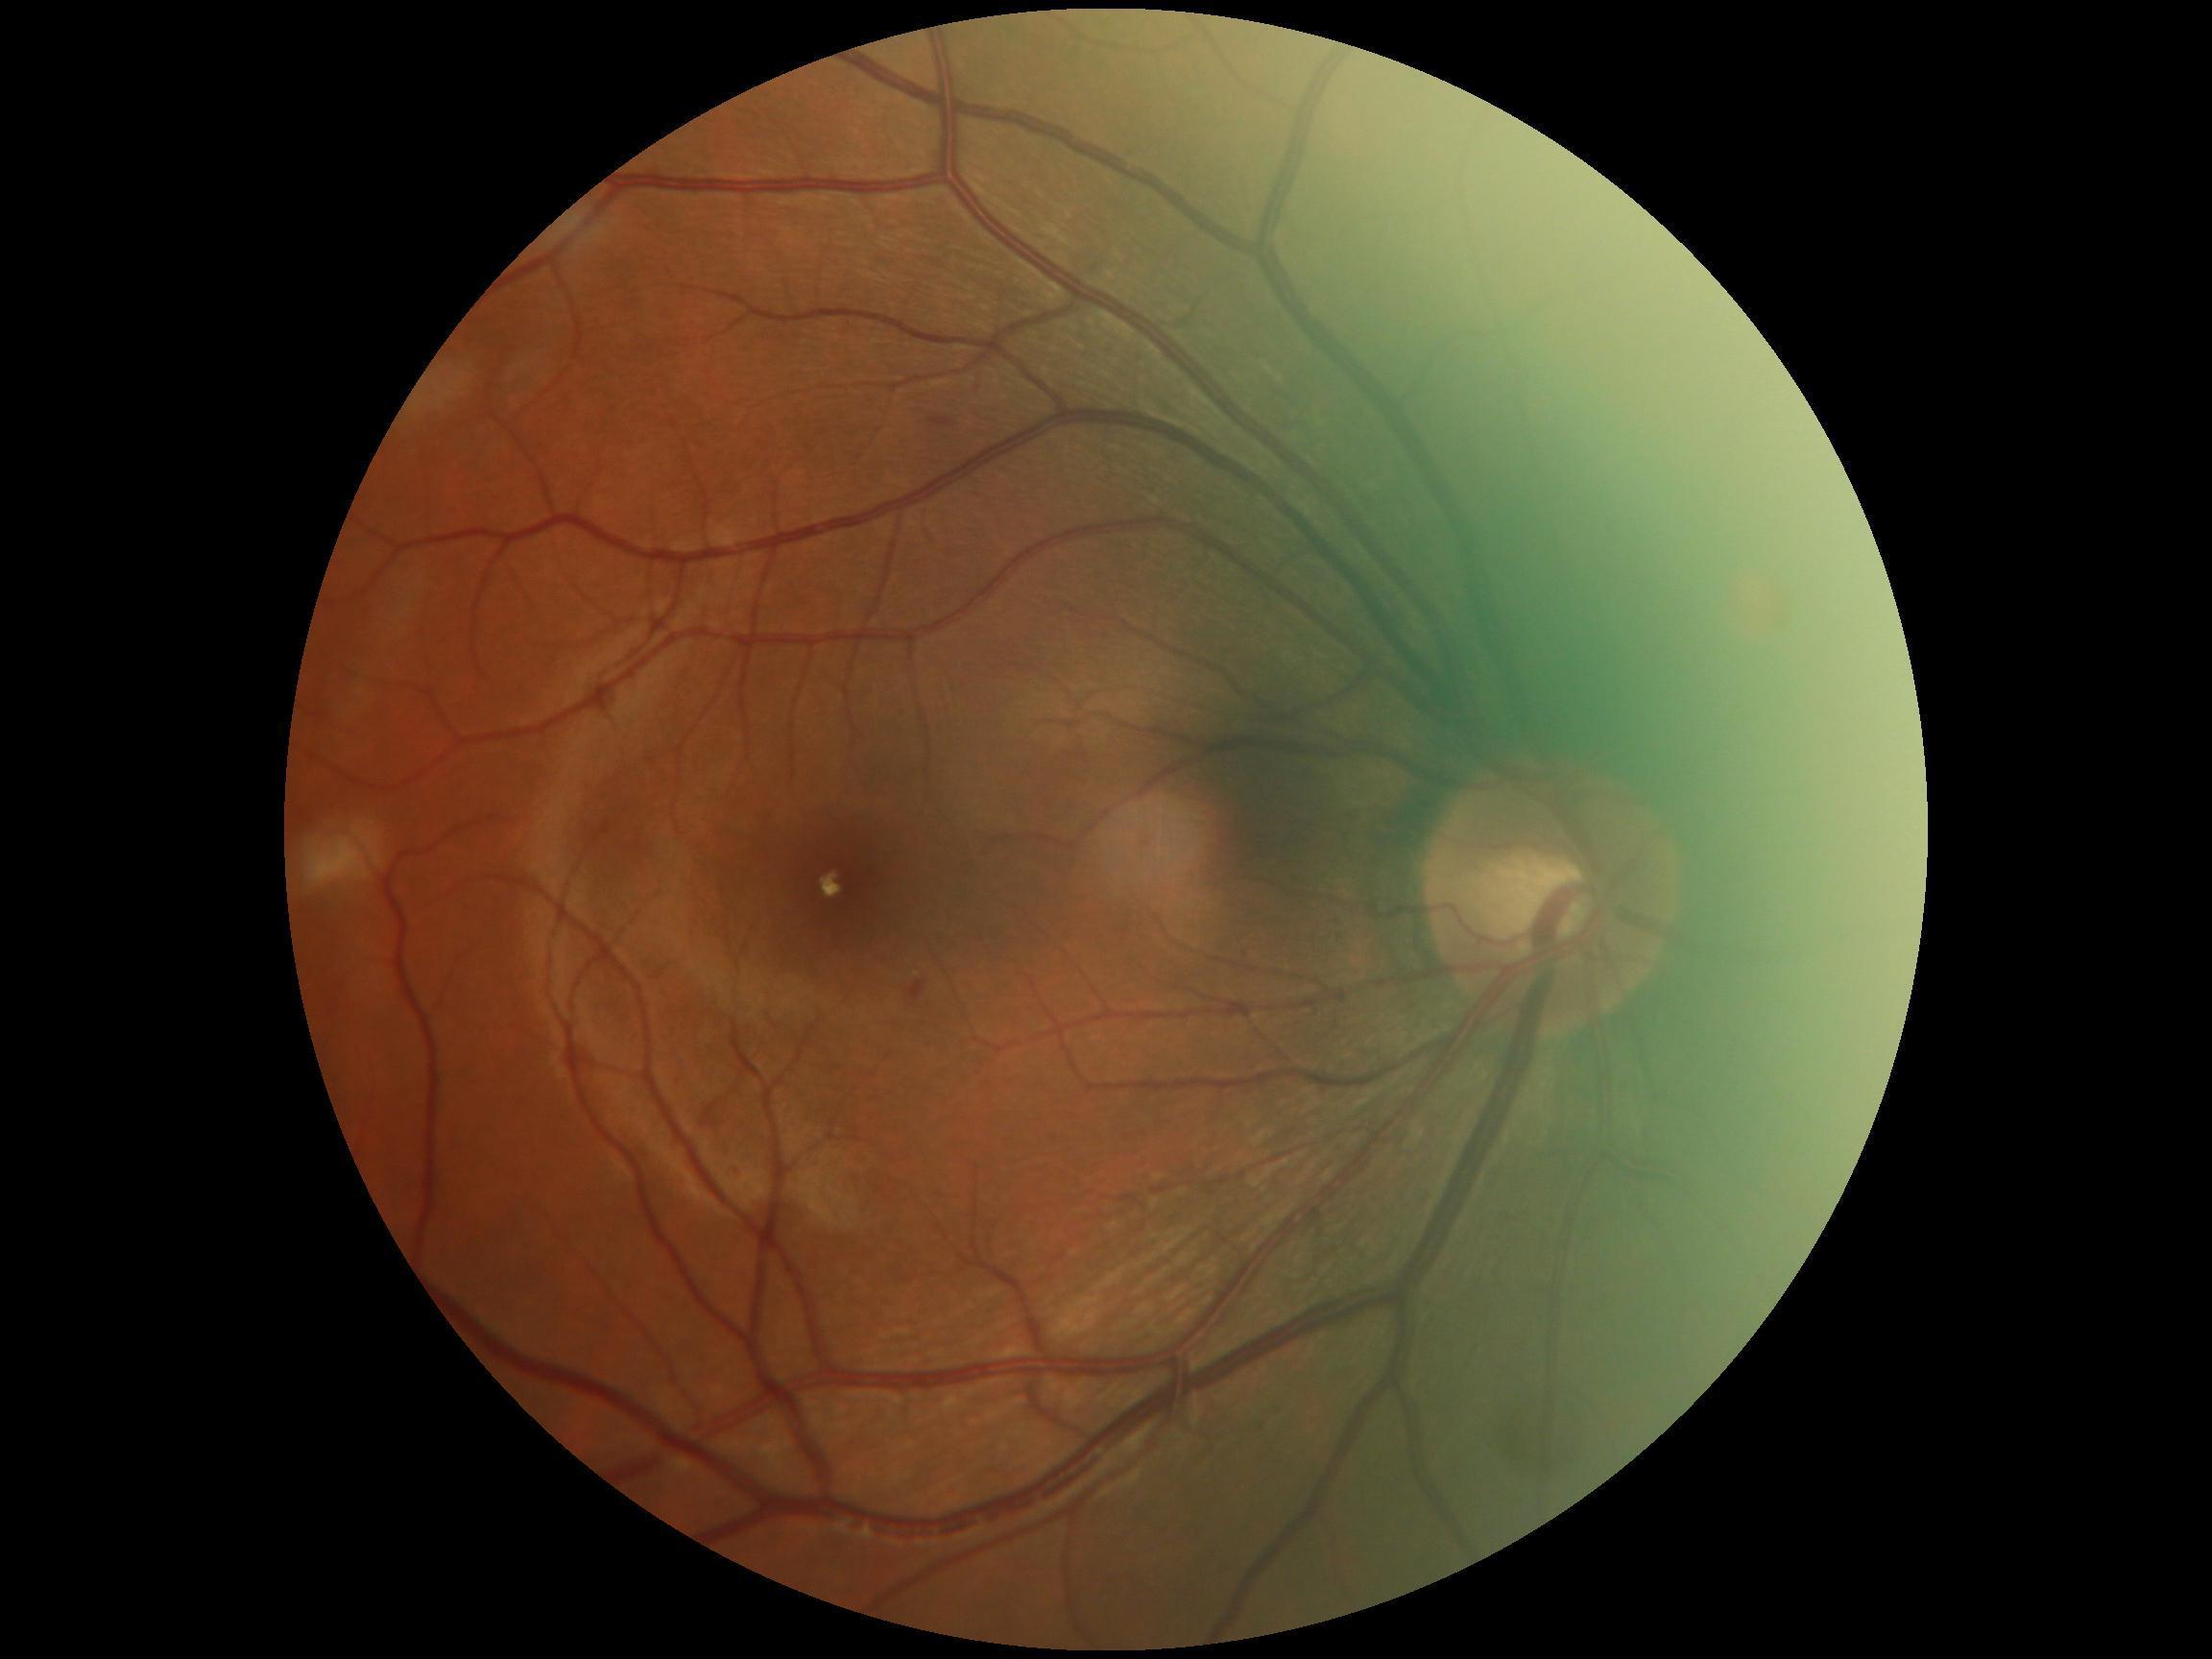 Disease class: non-proliferative diabetic retinopathy. DR severity is 2/4.